45° FOV. NIDEK AFC-230. Davis DR grading. Color fundus image: 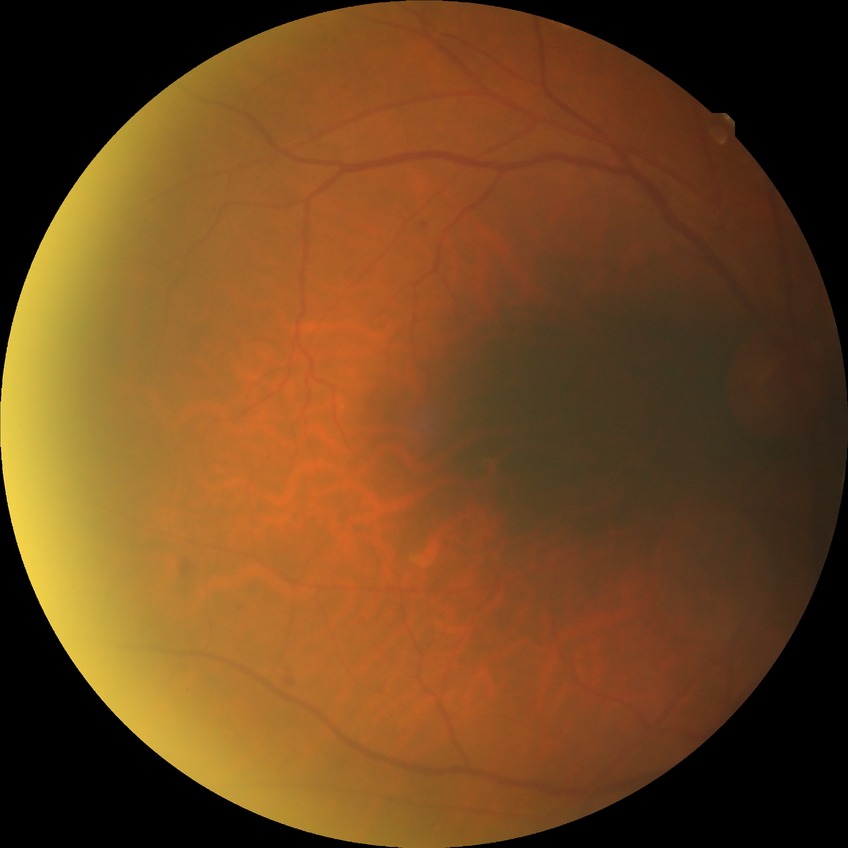
Davis DR grade is NDR.
No diabetic retinal disease findings.